Image size 2352x1568.
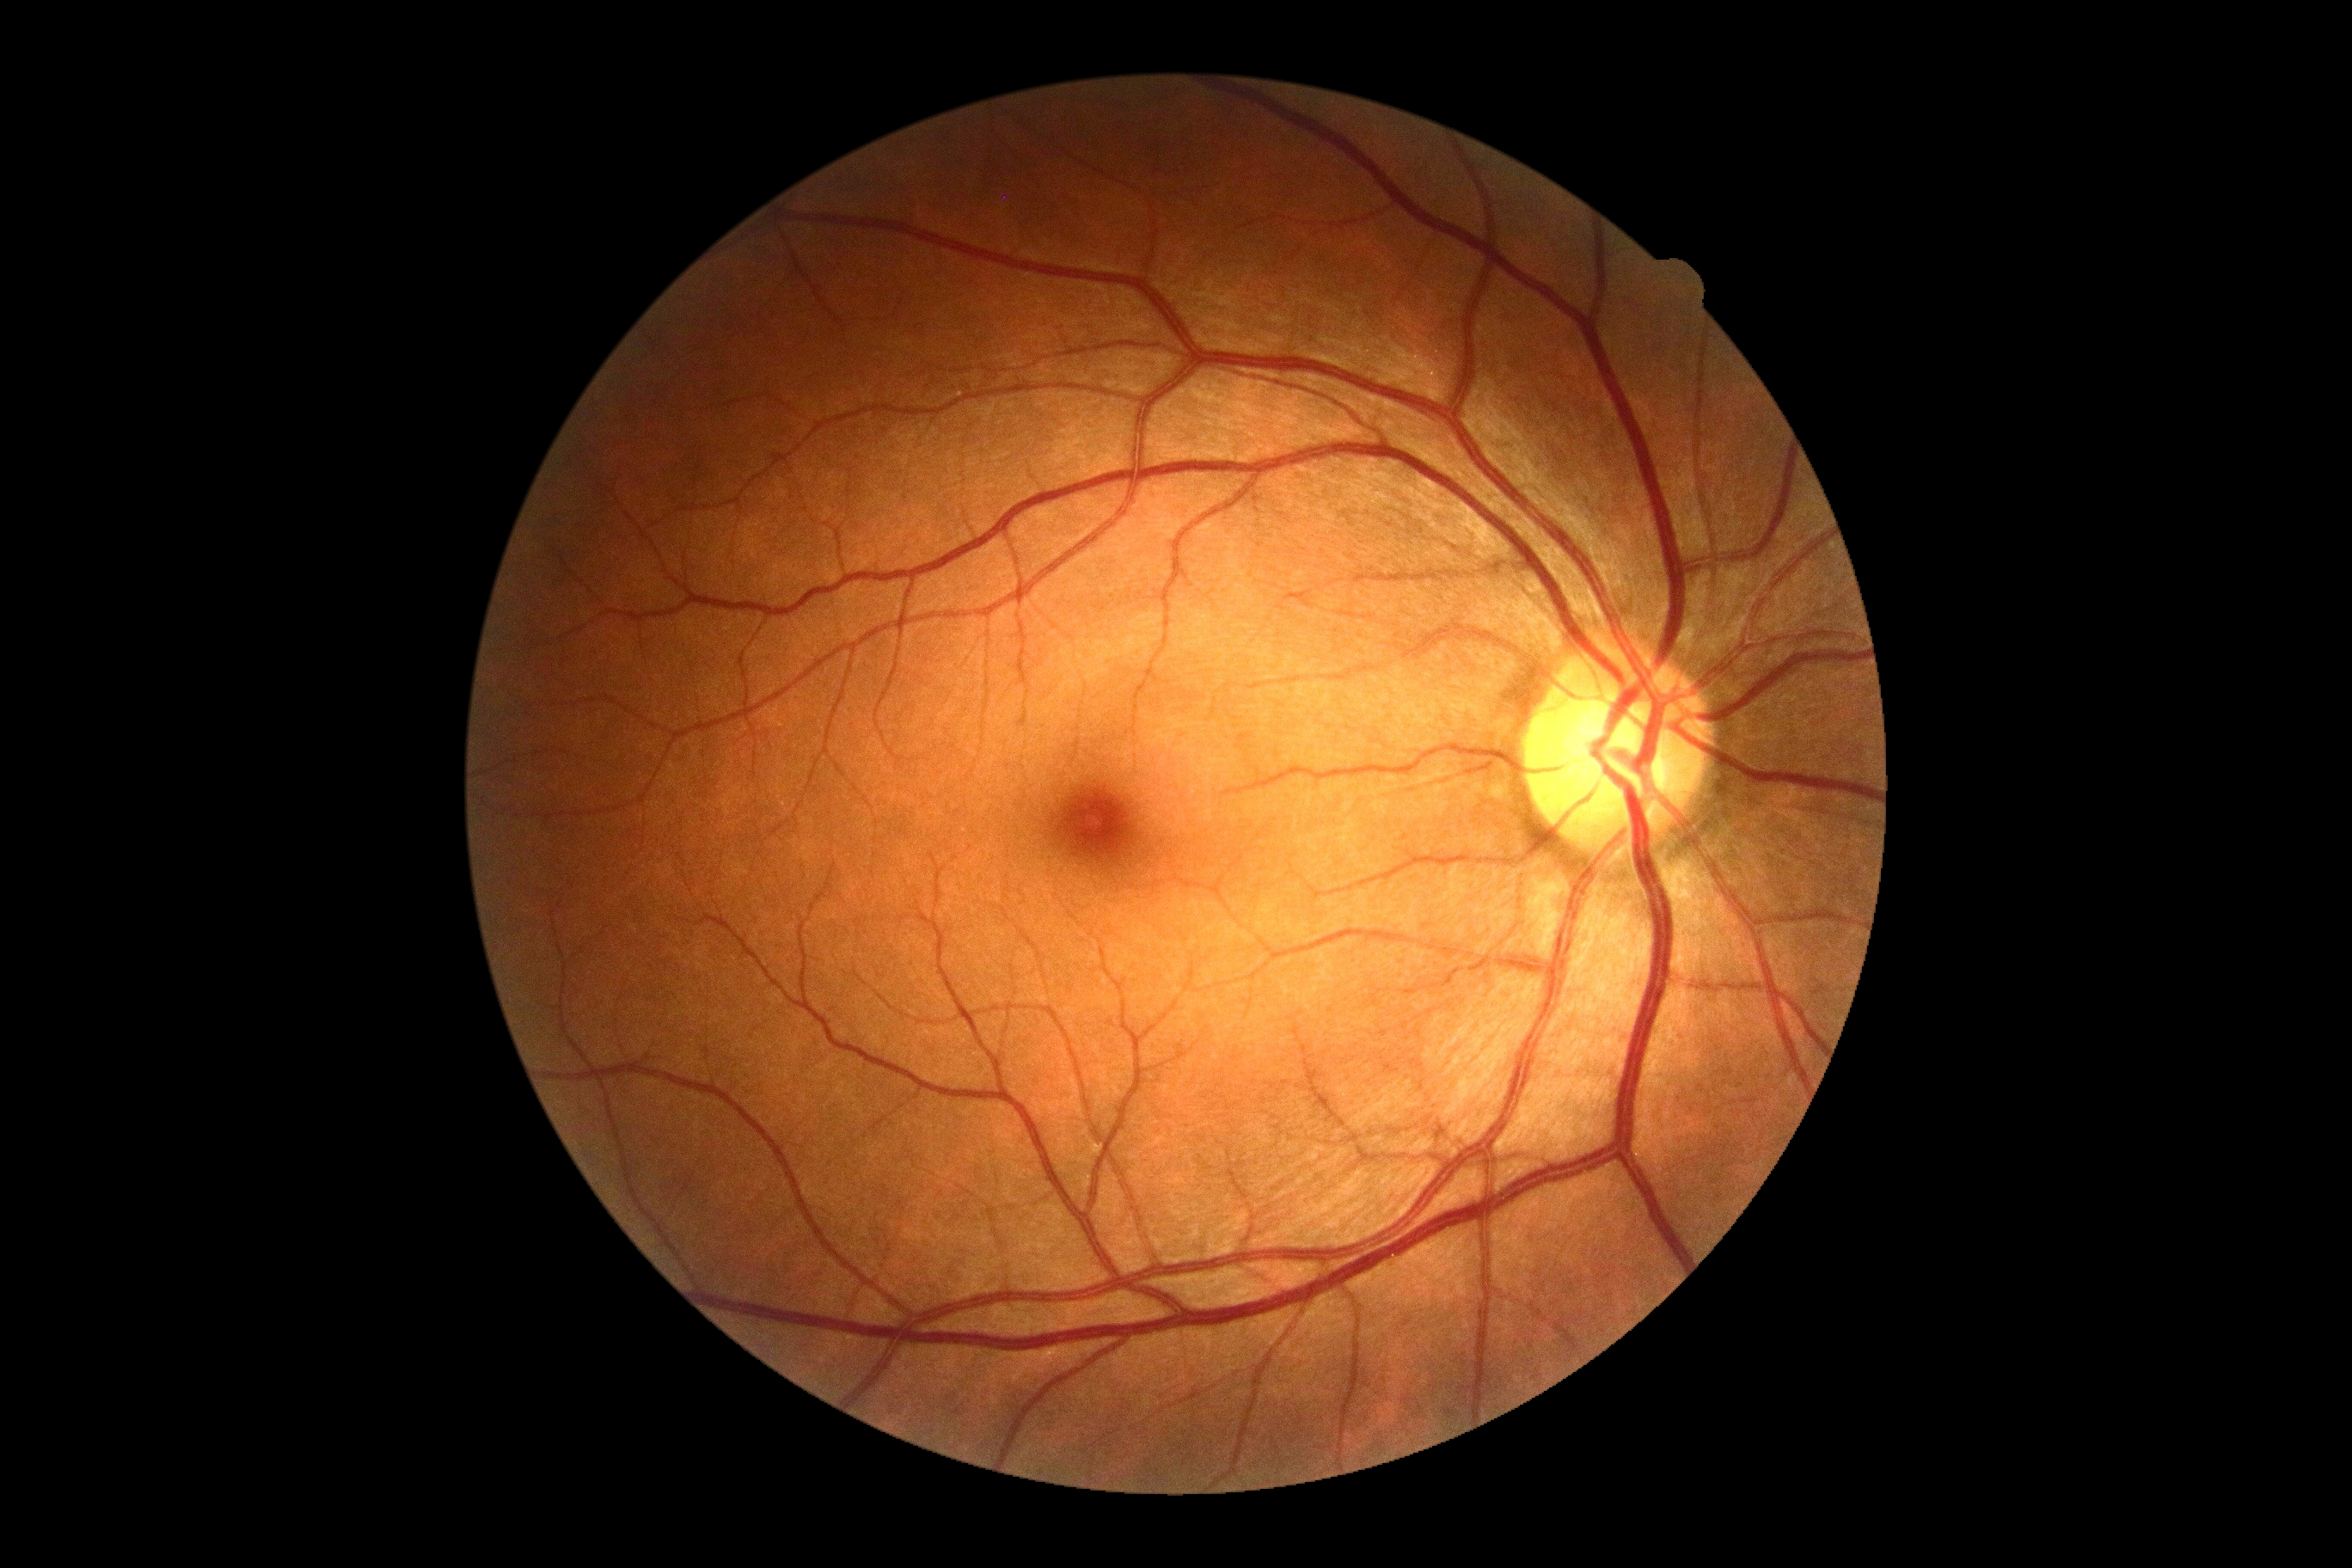 Diabetic retinopathy (DR): no apparent retinopathy (grade 0).